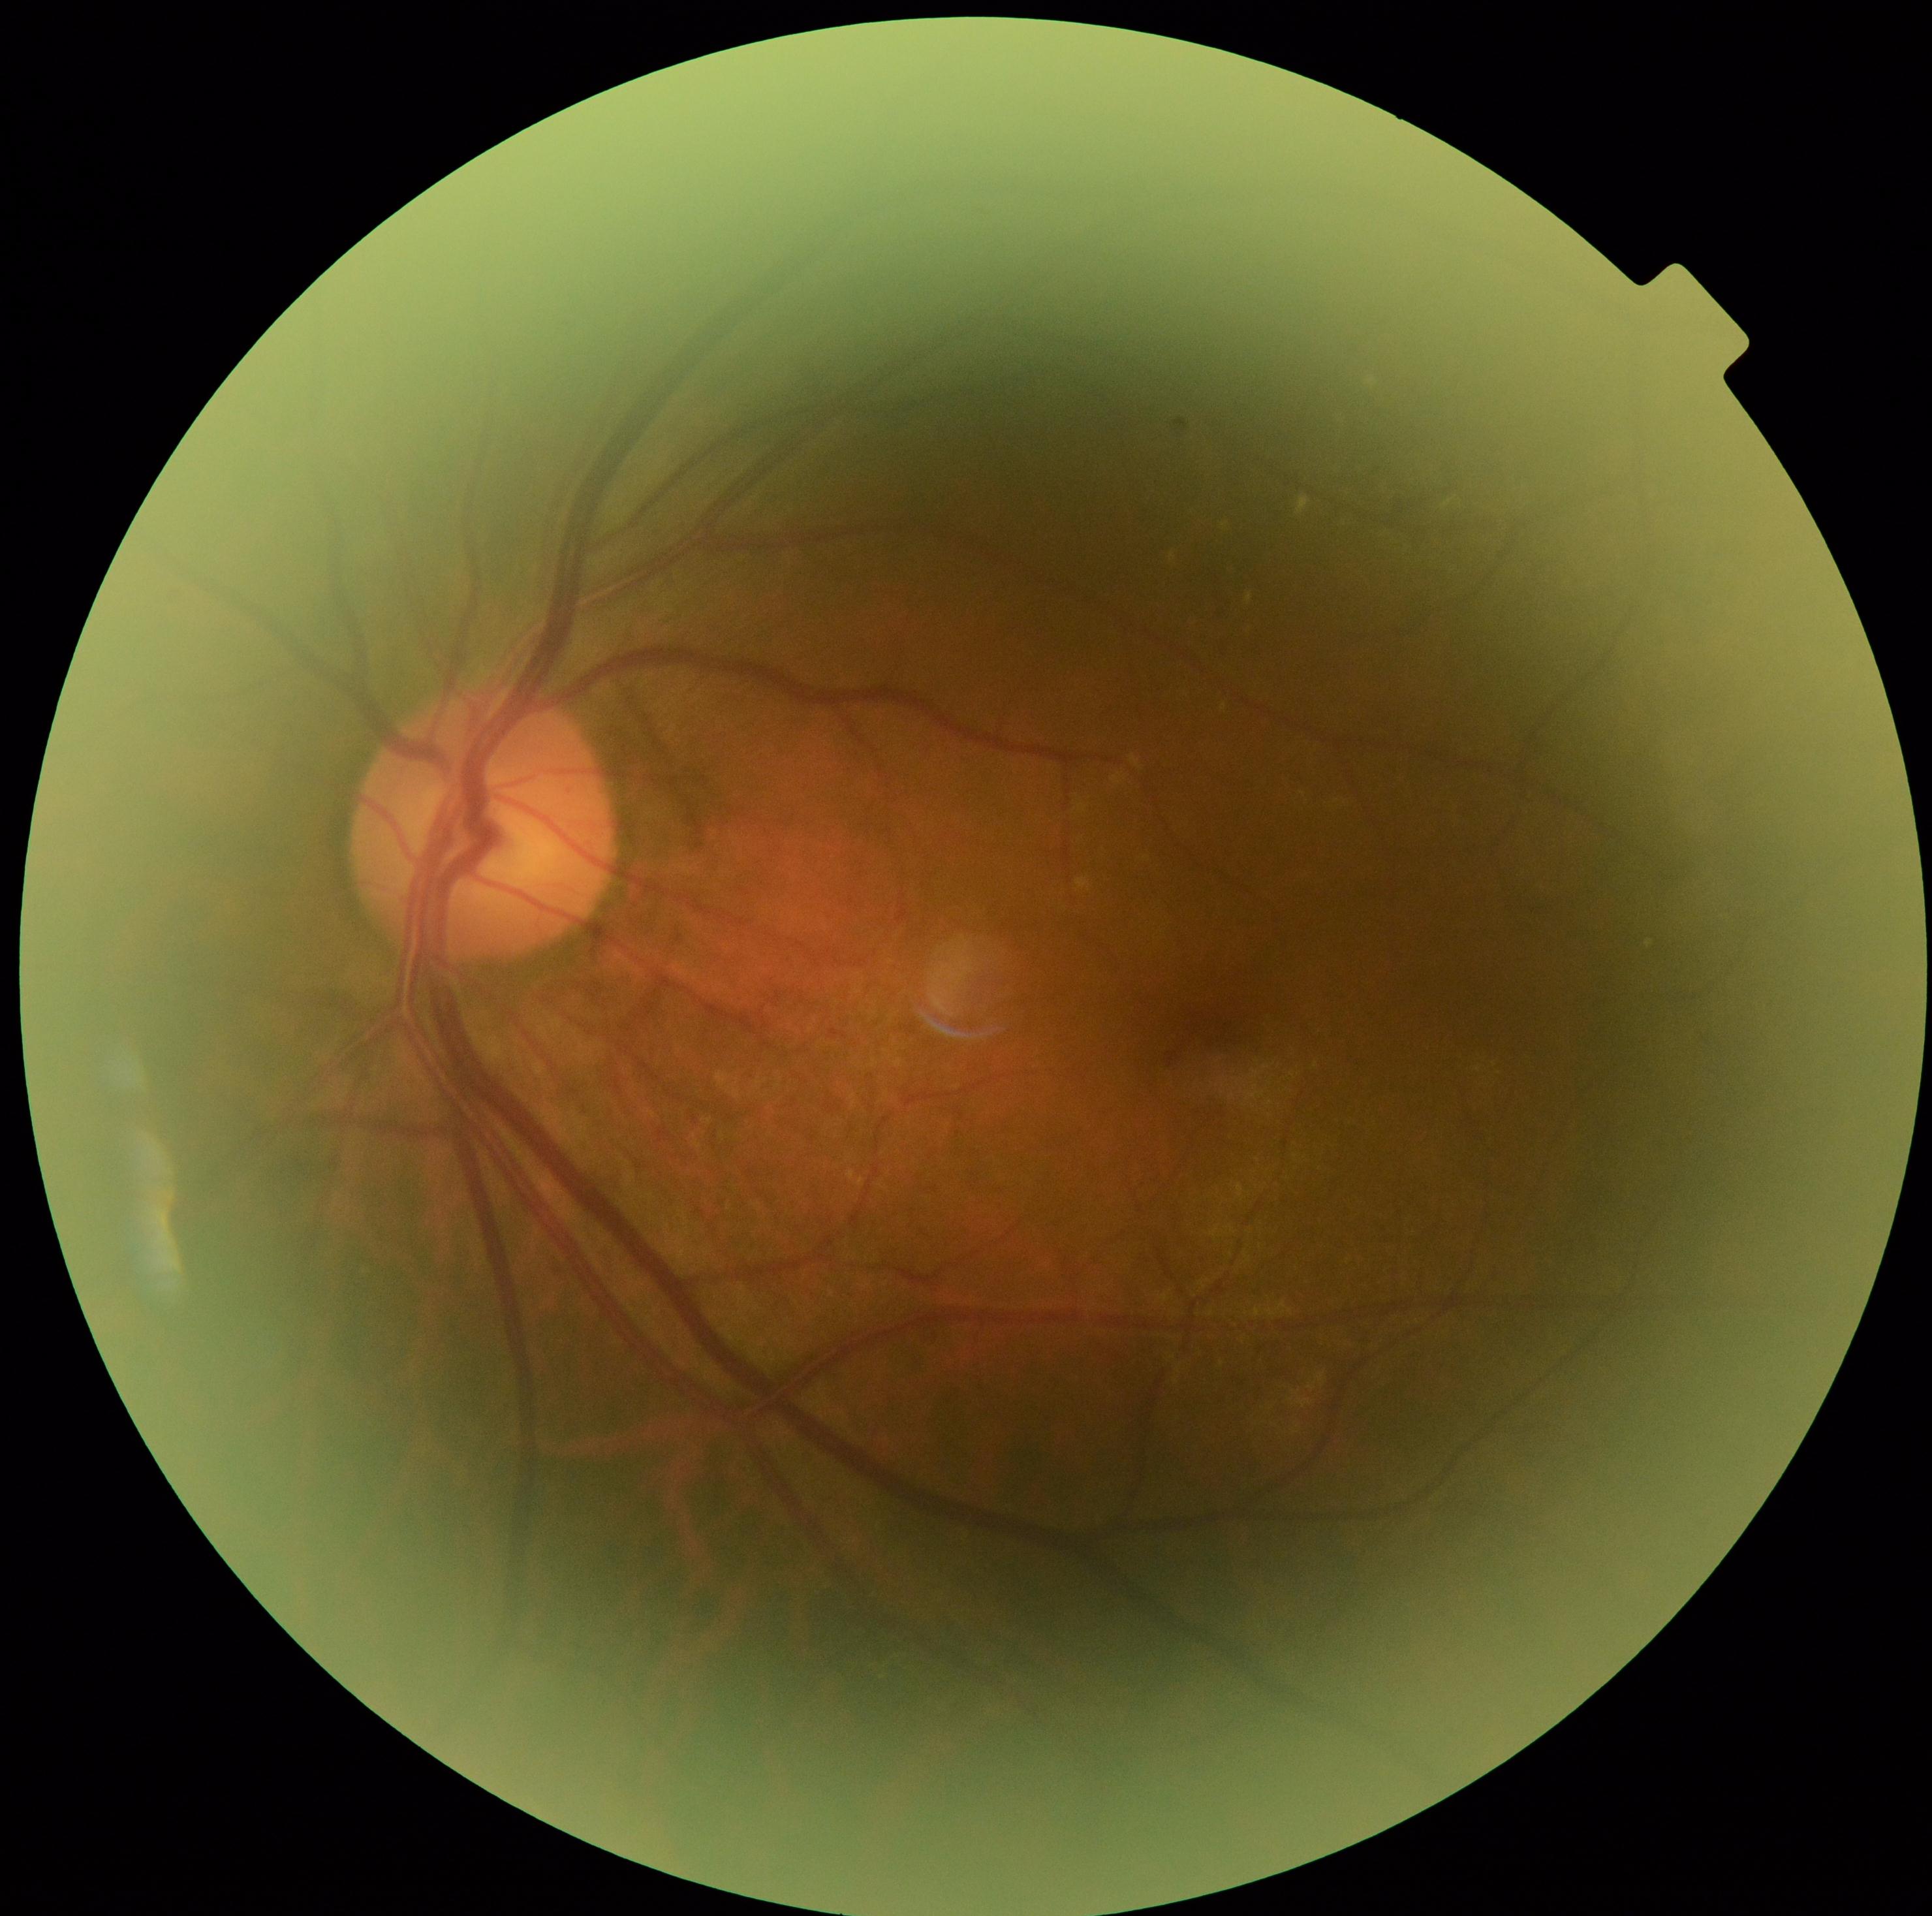 {
  "dr_grade": "moderate non-proliferative diabetic retinopathy (grade 2)"
}